Macula-centered:
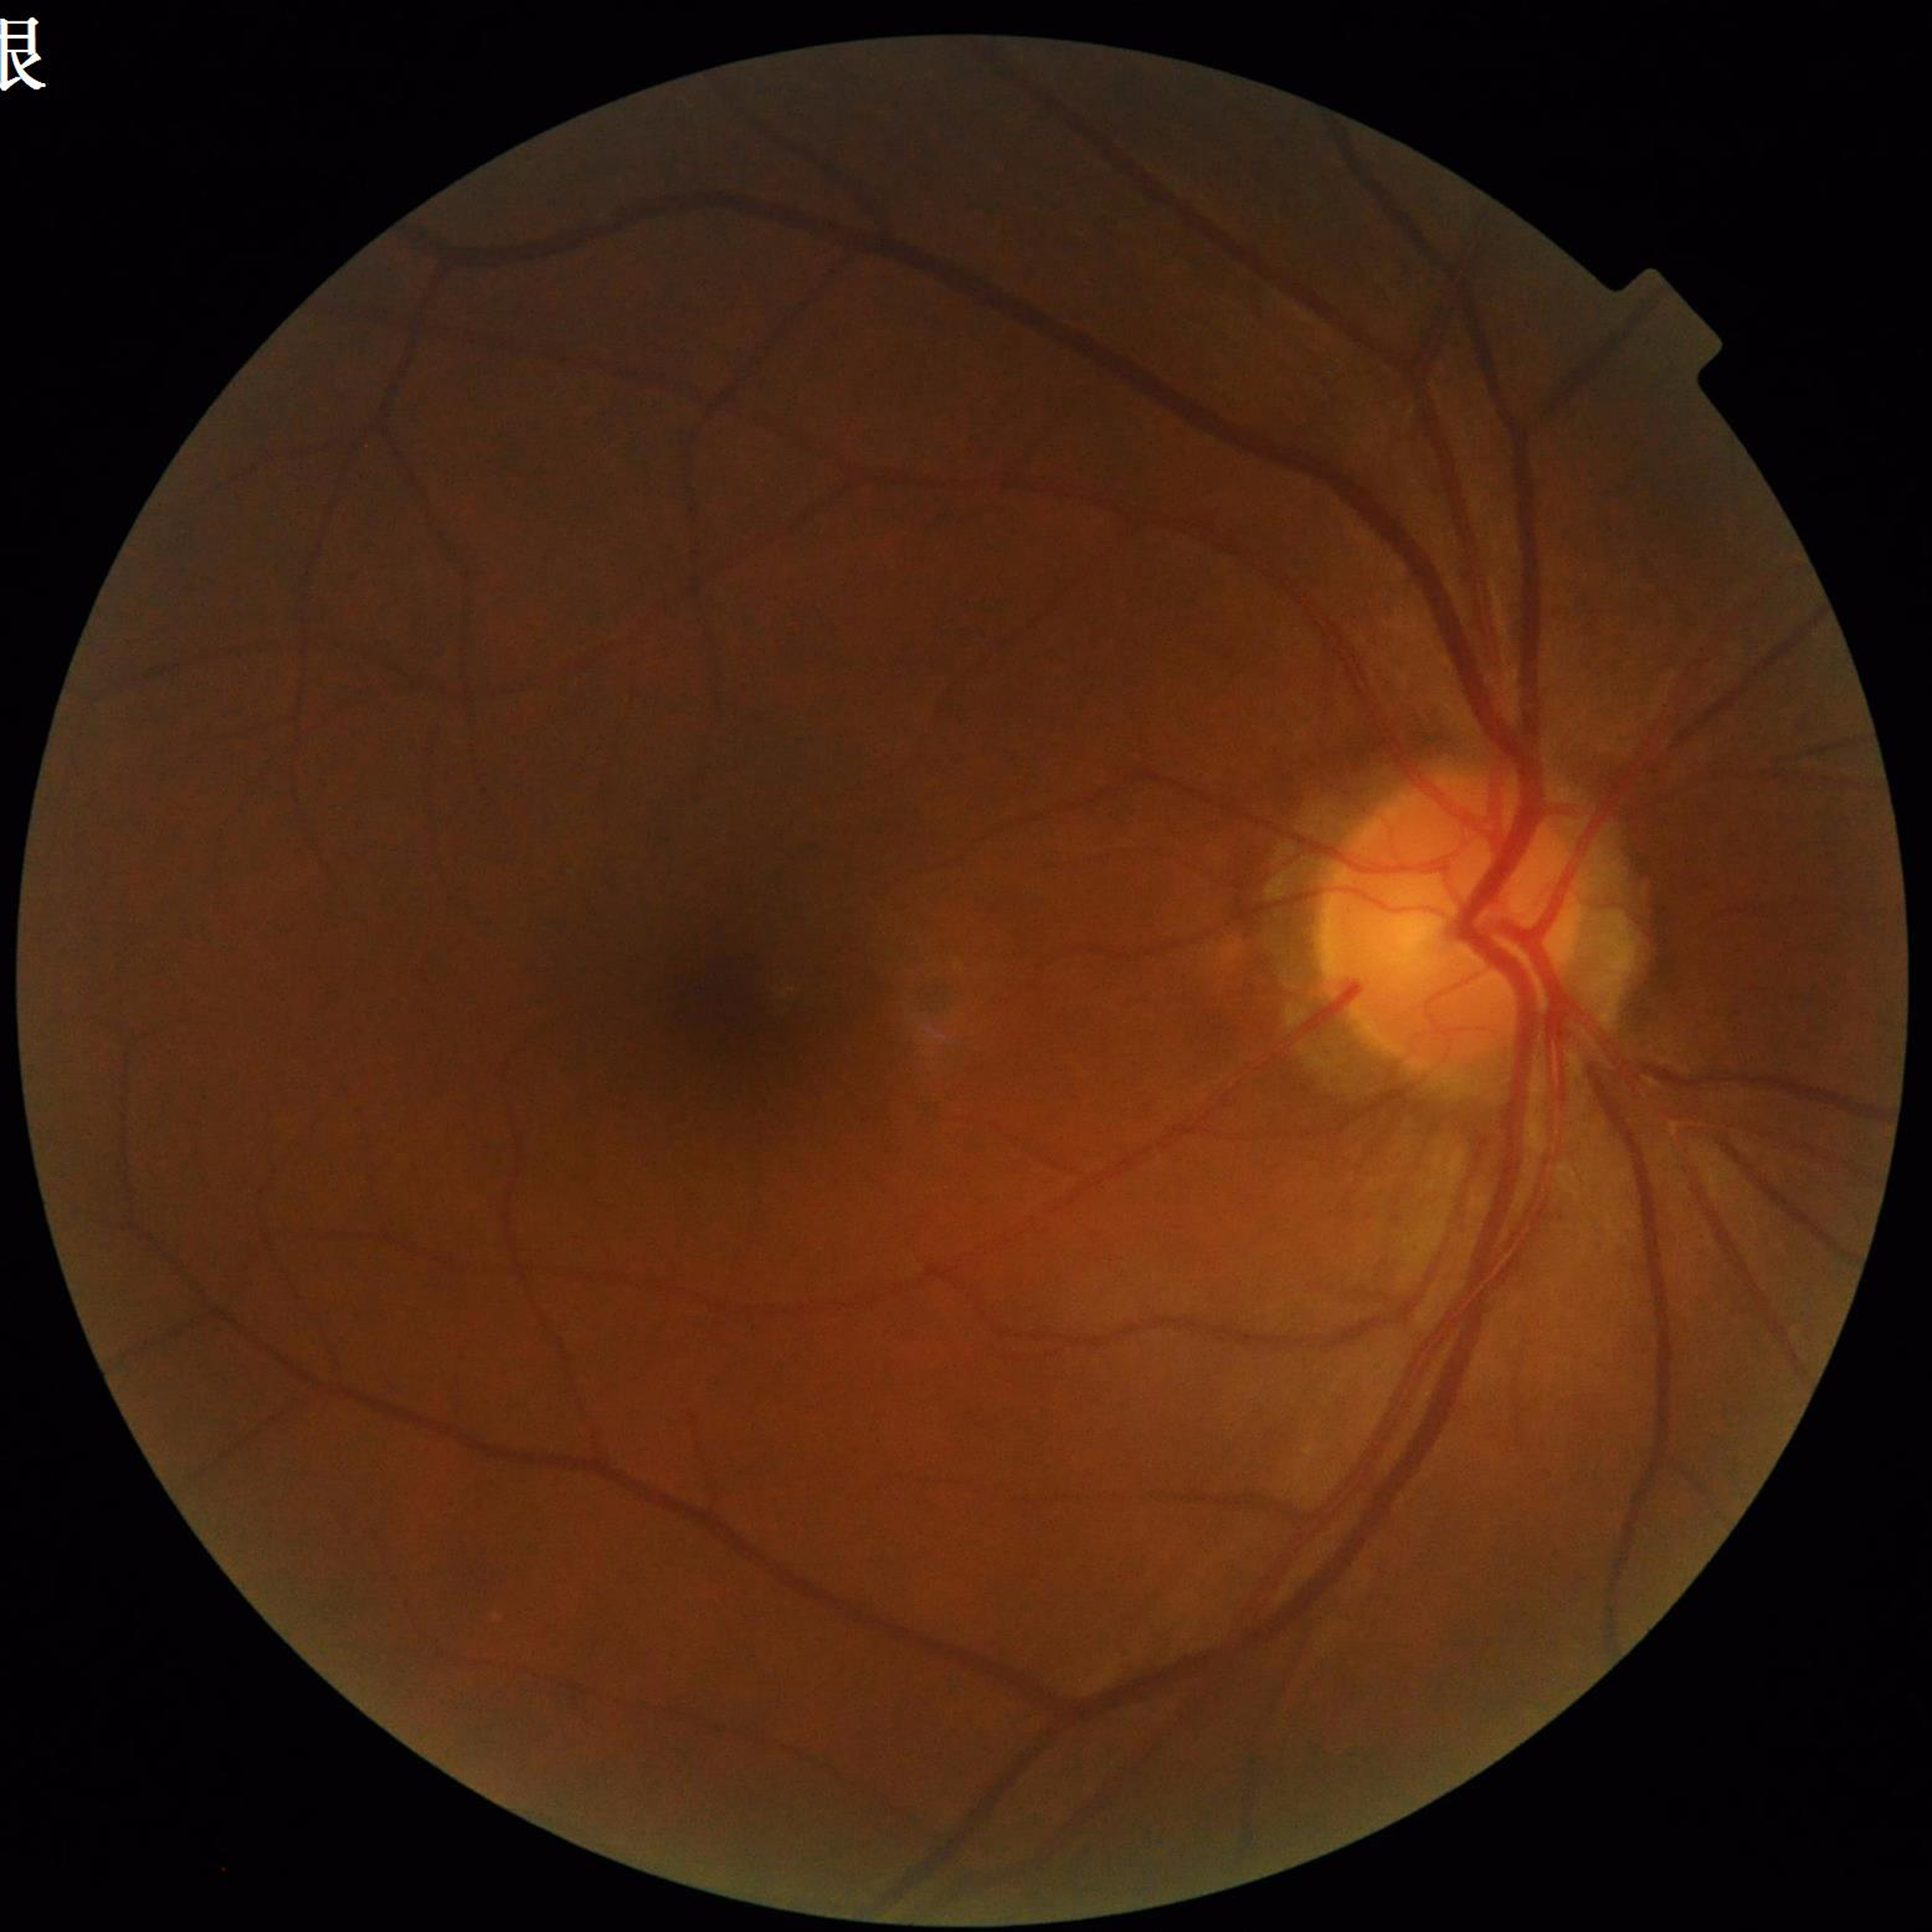 Clinical diagnosis: DR.